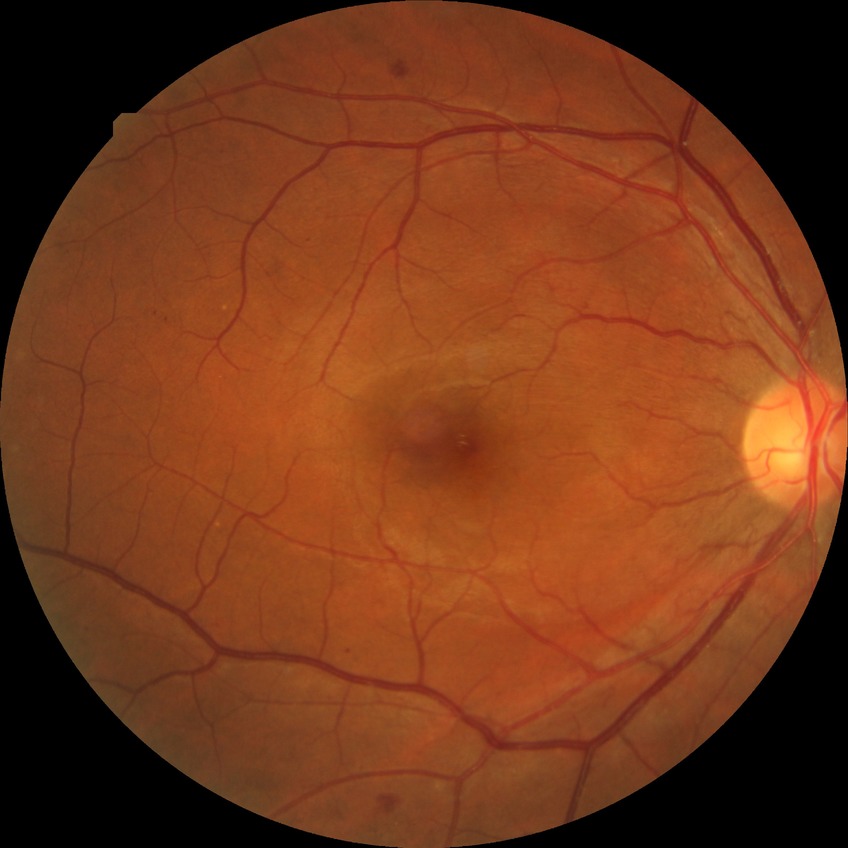

Annotations:
* diabetic retinopathy (DR) — SDR (simple diabetic retinopathy)
* DR class — non-proliferative diabetic retinopathy